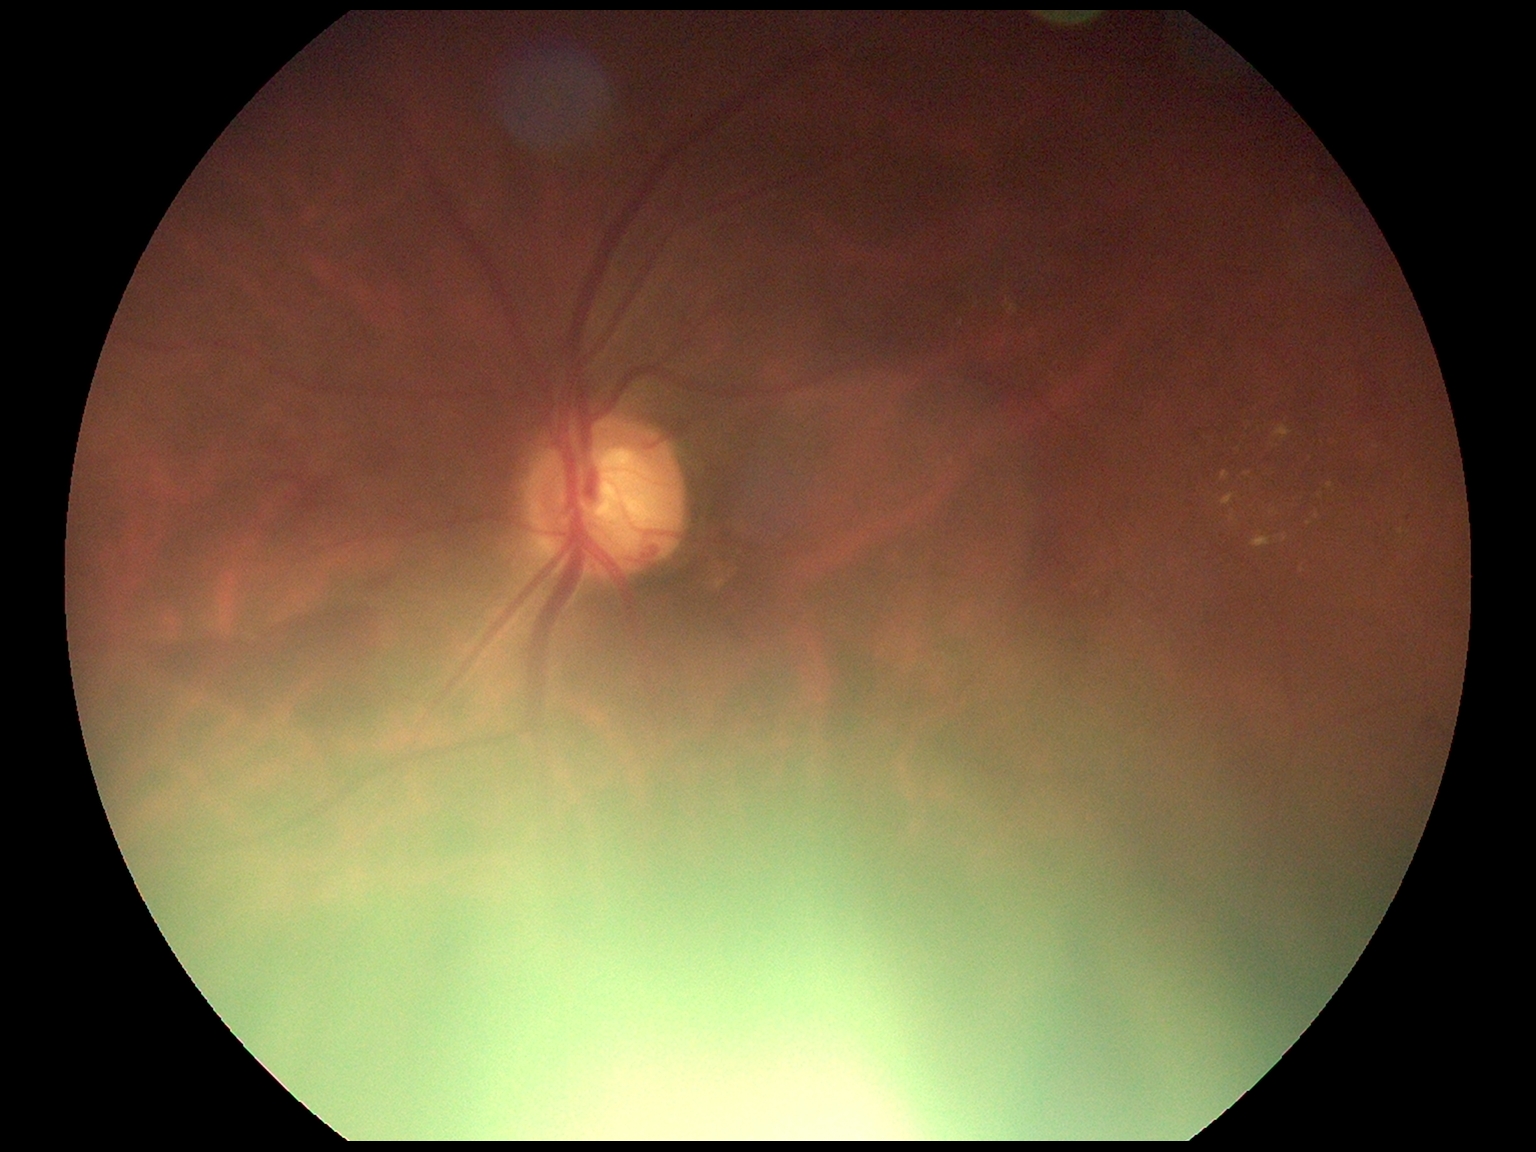

retinopathy = grade 2 — more than just microaneurysms but less than severe NPDR.